Acquired with a NIDEK AFC-230 · 45 degree fundus photograph: 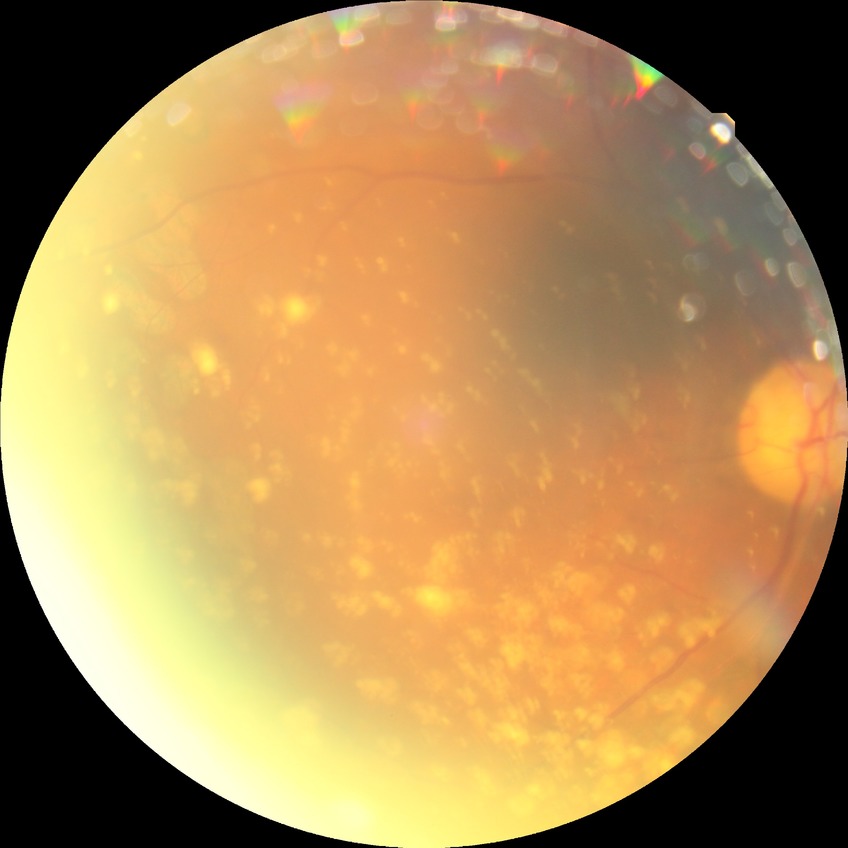   davis_grade: proliferative diabetic retinopathy